277x277px. Optic disc region of a color fundus photo.
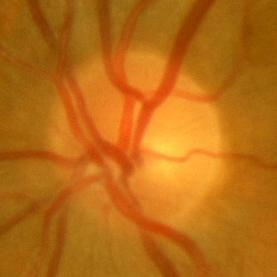
No glaucomatous damage.